No pharmacologic dilation: 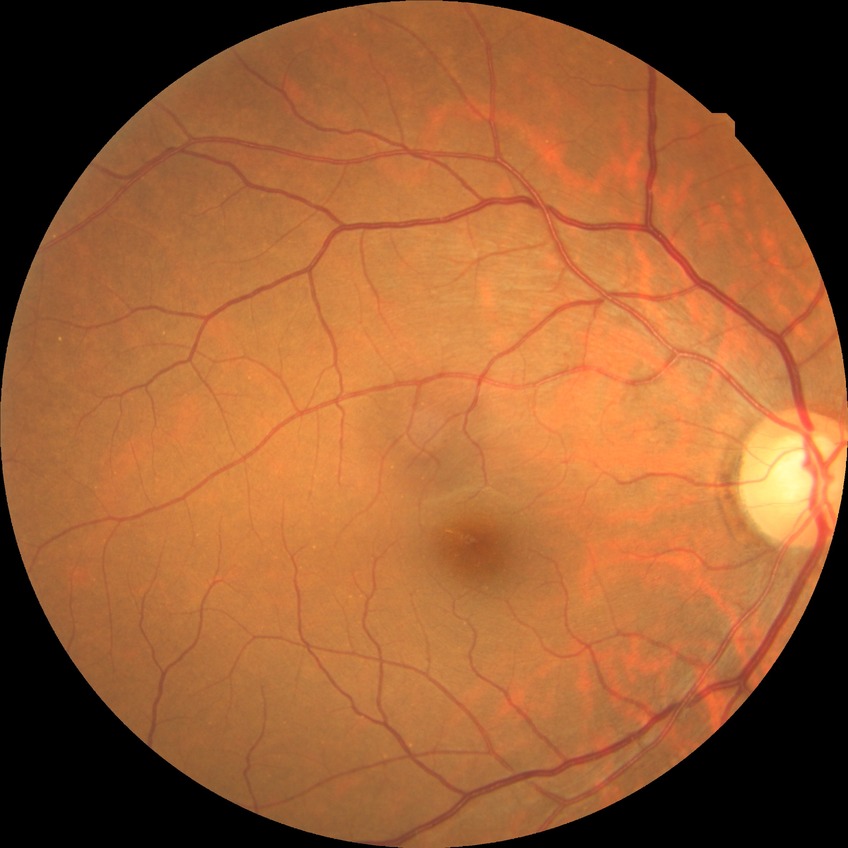

Diabetic retinopathy (DR) is NDR (no diabetic retinopathy).